Wide-field fundus image from infant ROP screening:
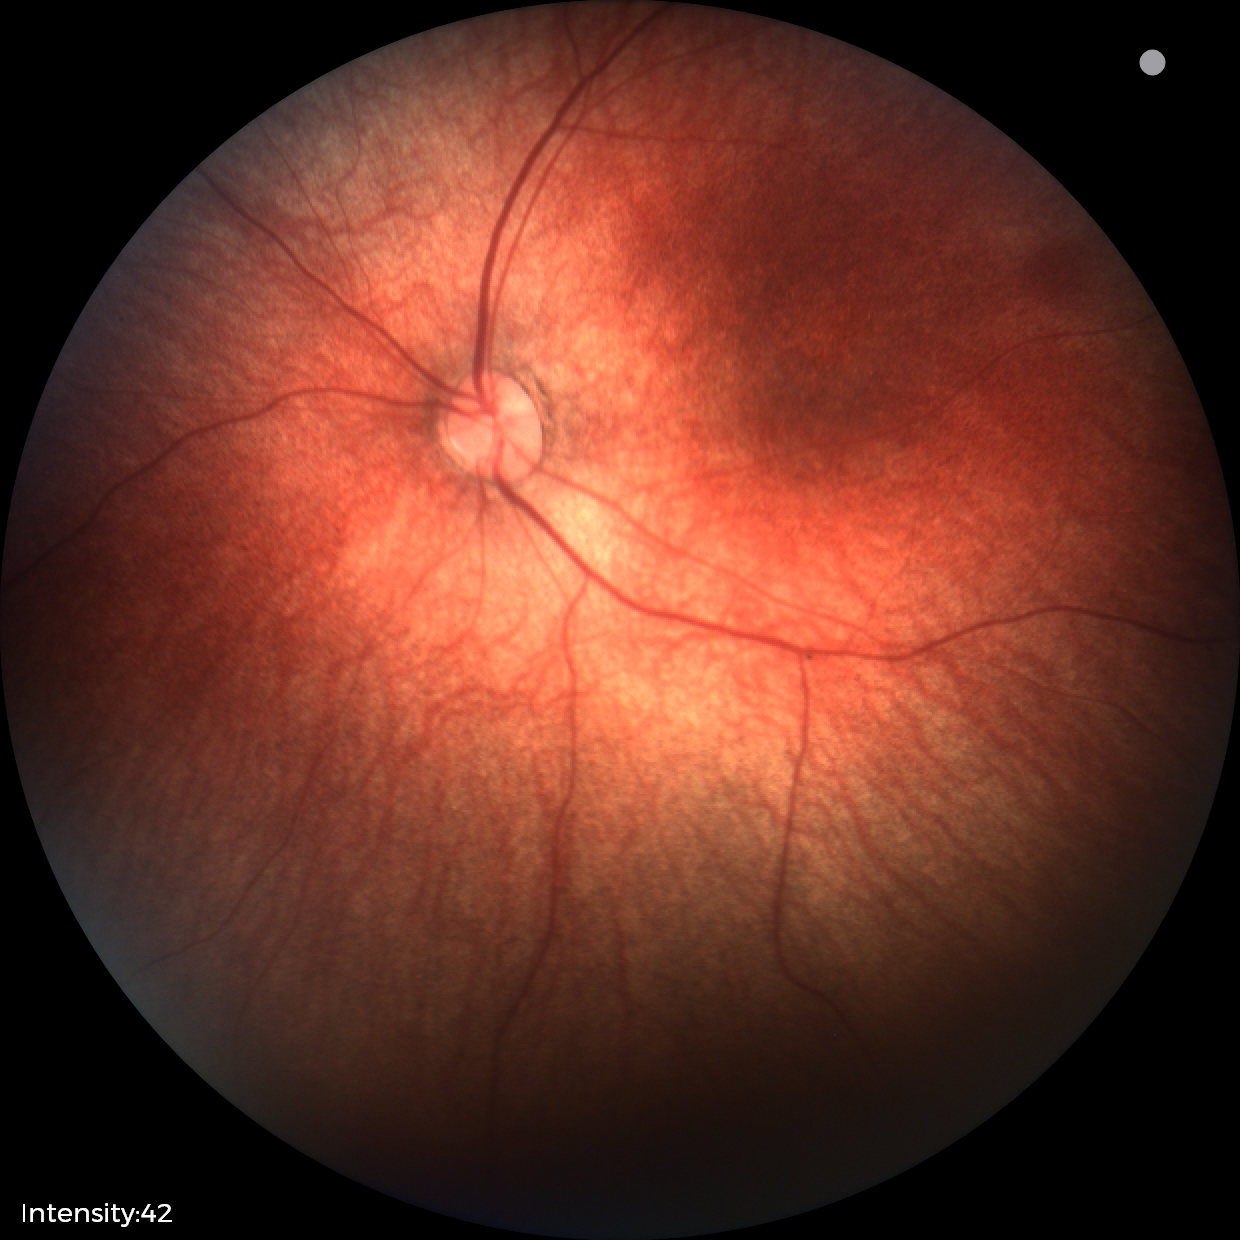

No retinal pathology identified on screening.